DR severity per modified Davis staging: 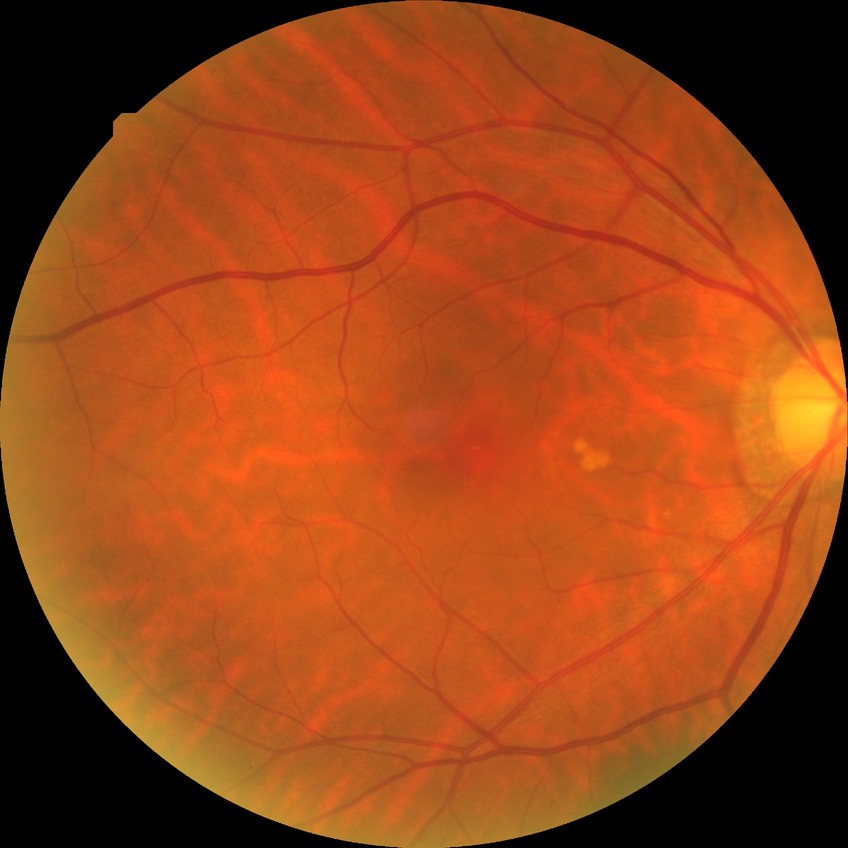 modified Davis classification = no diabetic retinopathy.